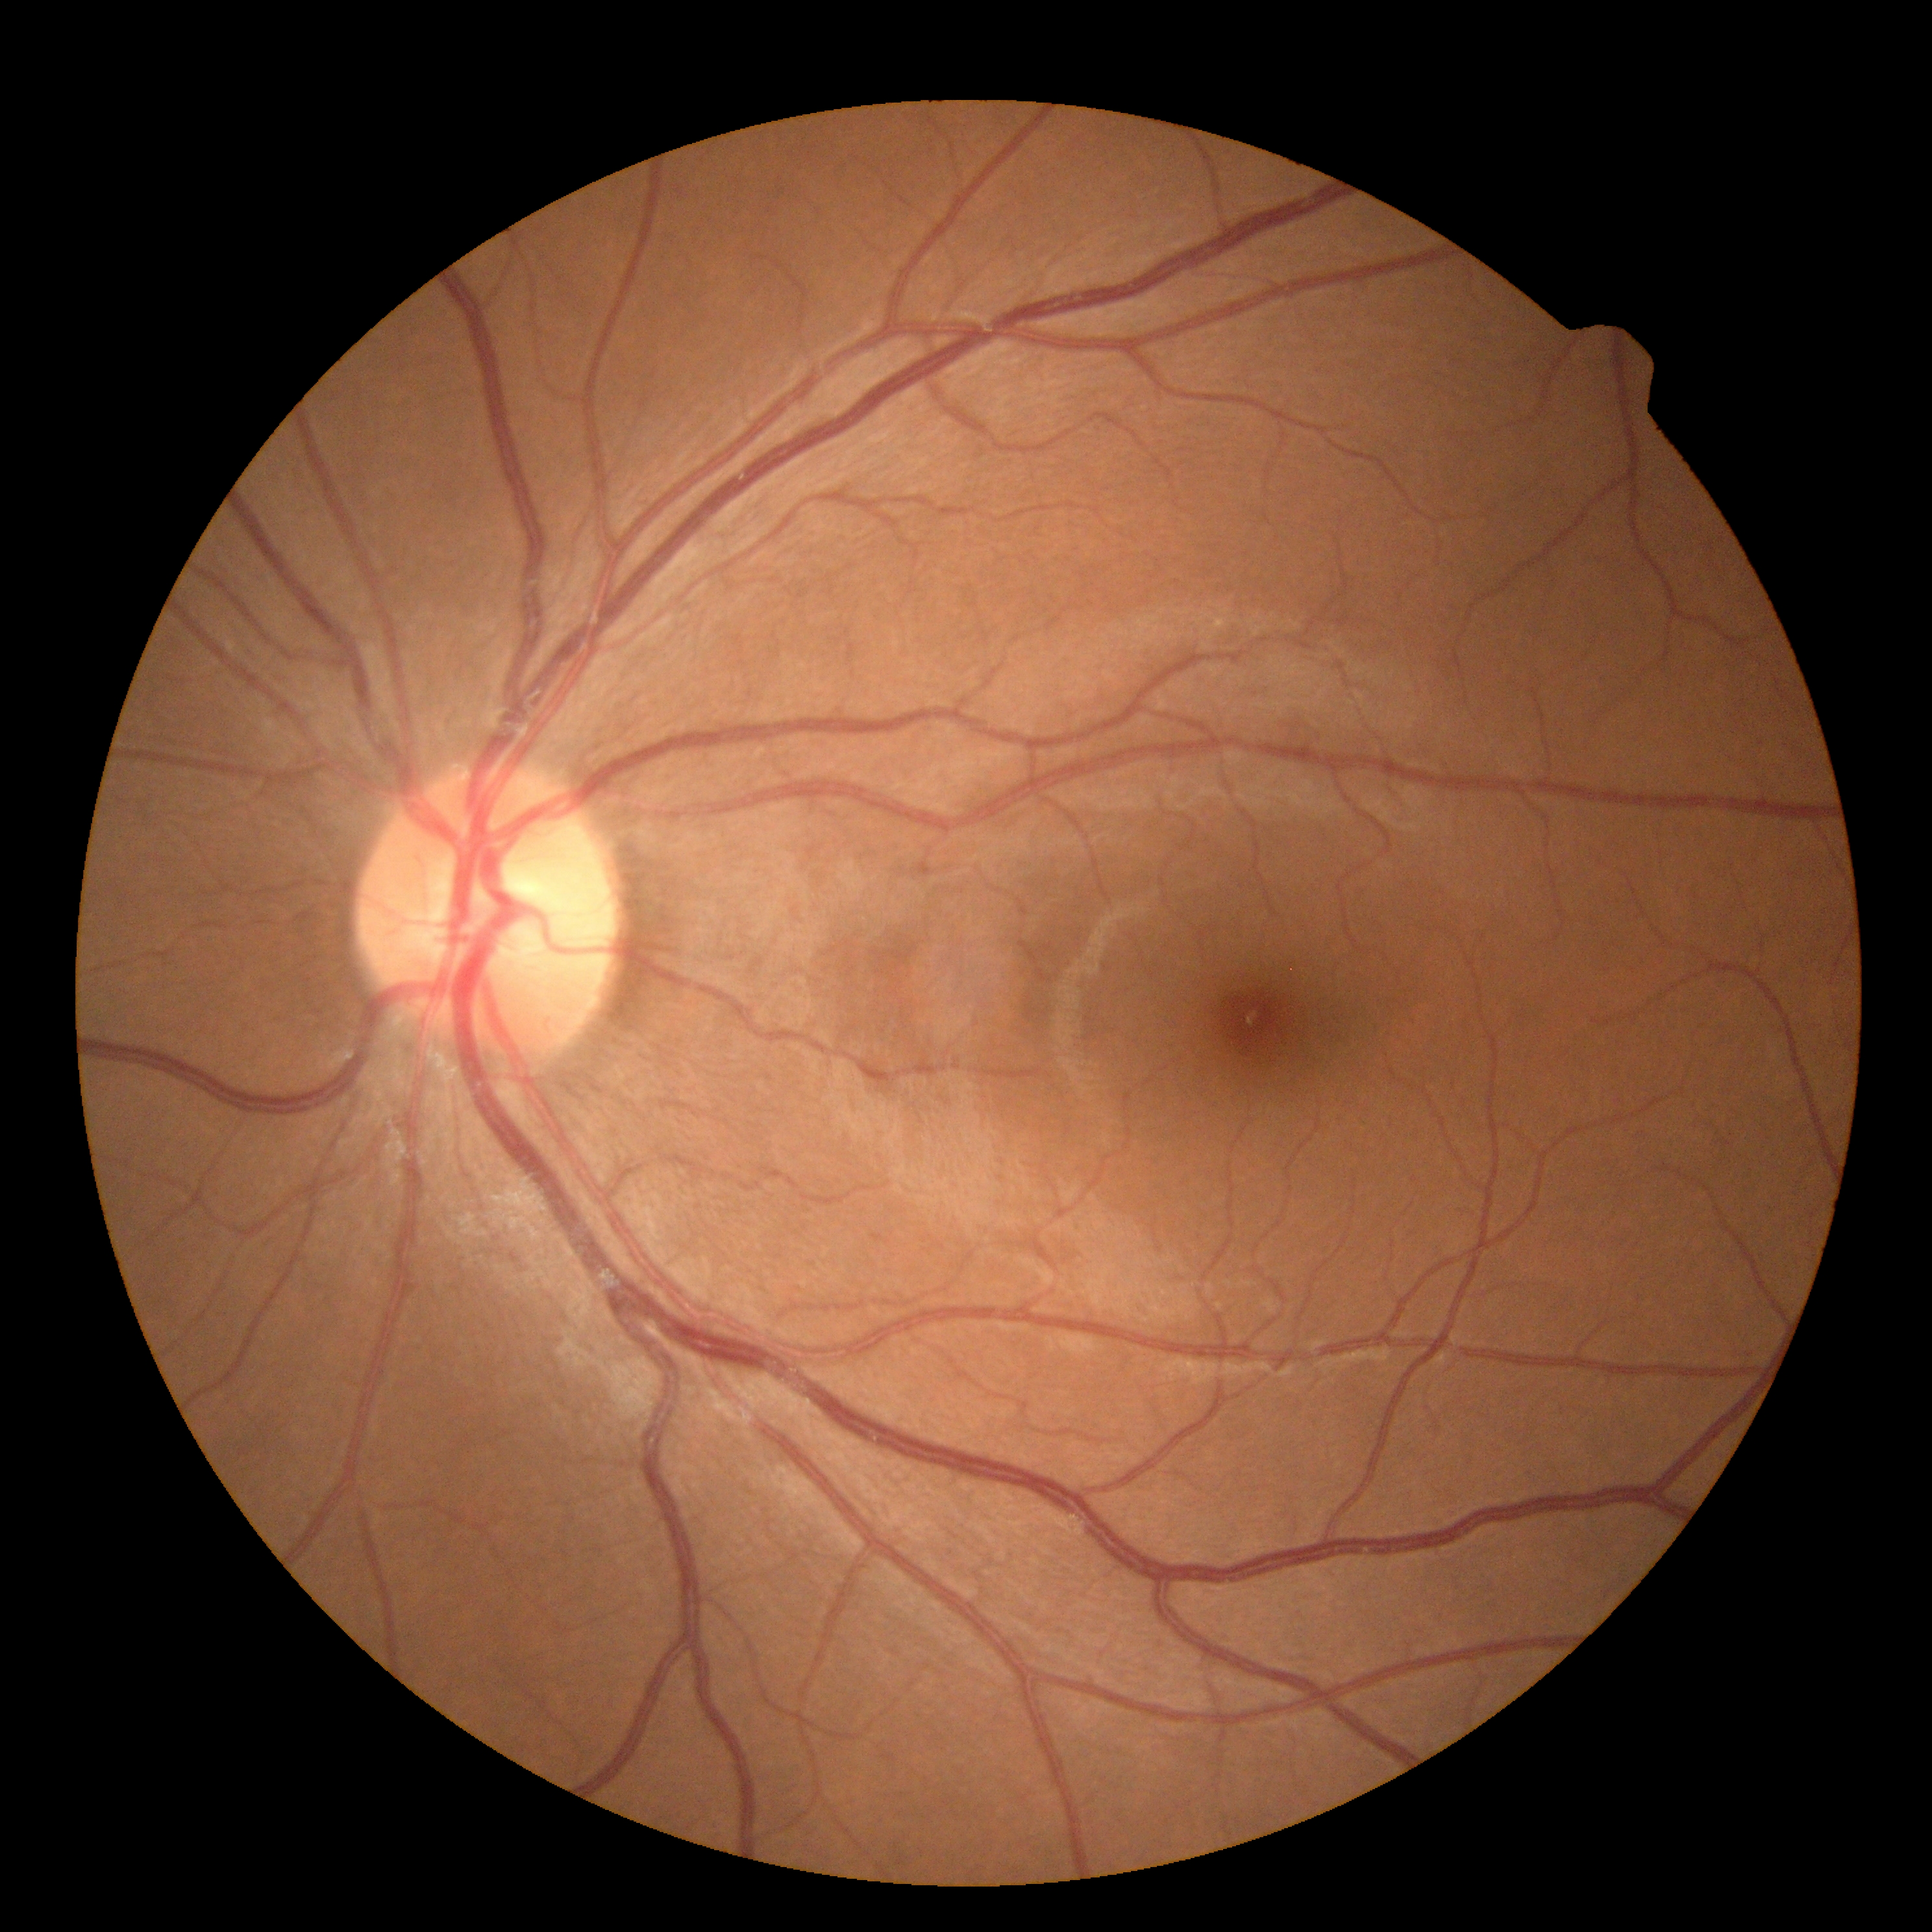
DR impression = no signs of DR; DR = 0.